Wide-field fundus photograph of an infant · 1240x1240px:
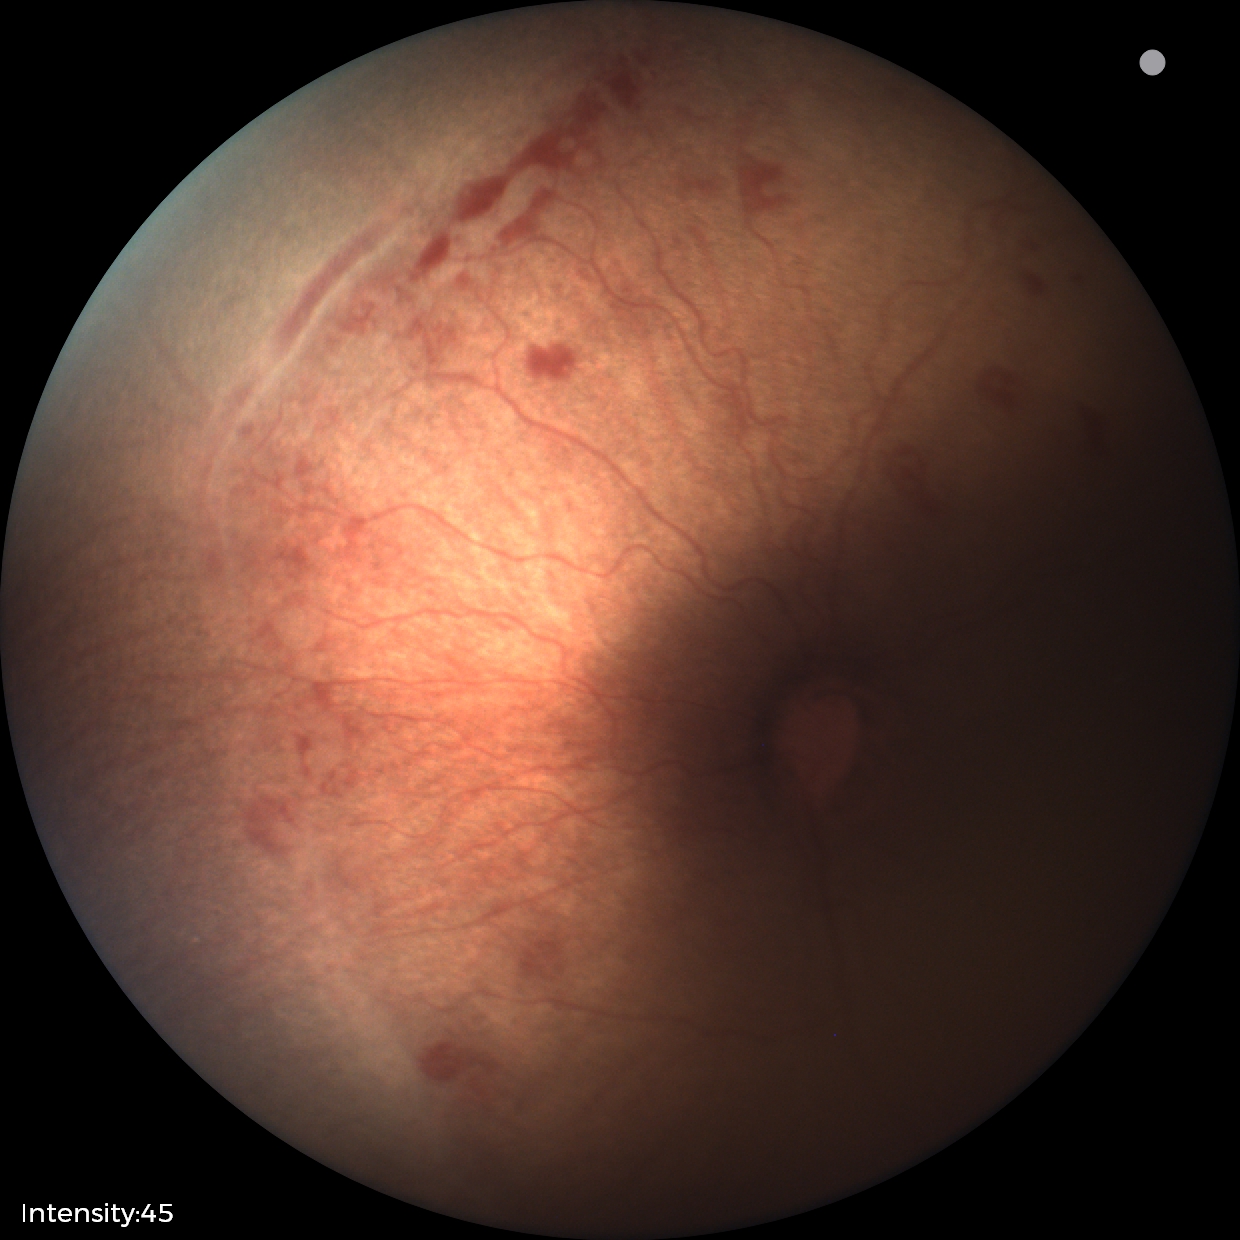

Screening series with ROP stage 1 — demarcation line between vascular and avascular retina. No plus disease.